Camera: Natus RetCam Envision (130° FOV) · wide-field fundus photograph of an infant · image size 1440x1080 — 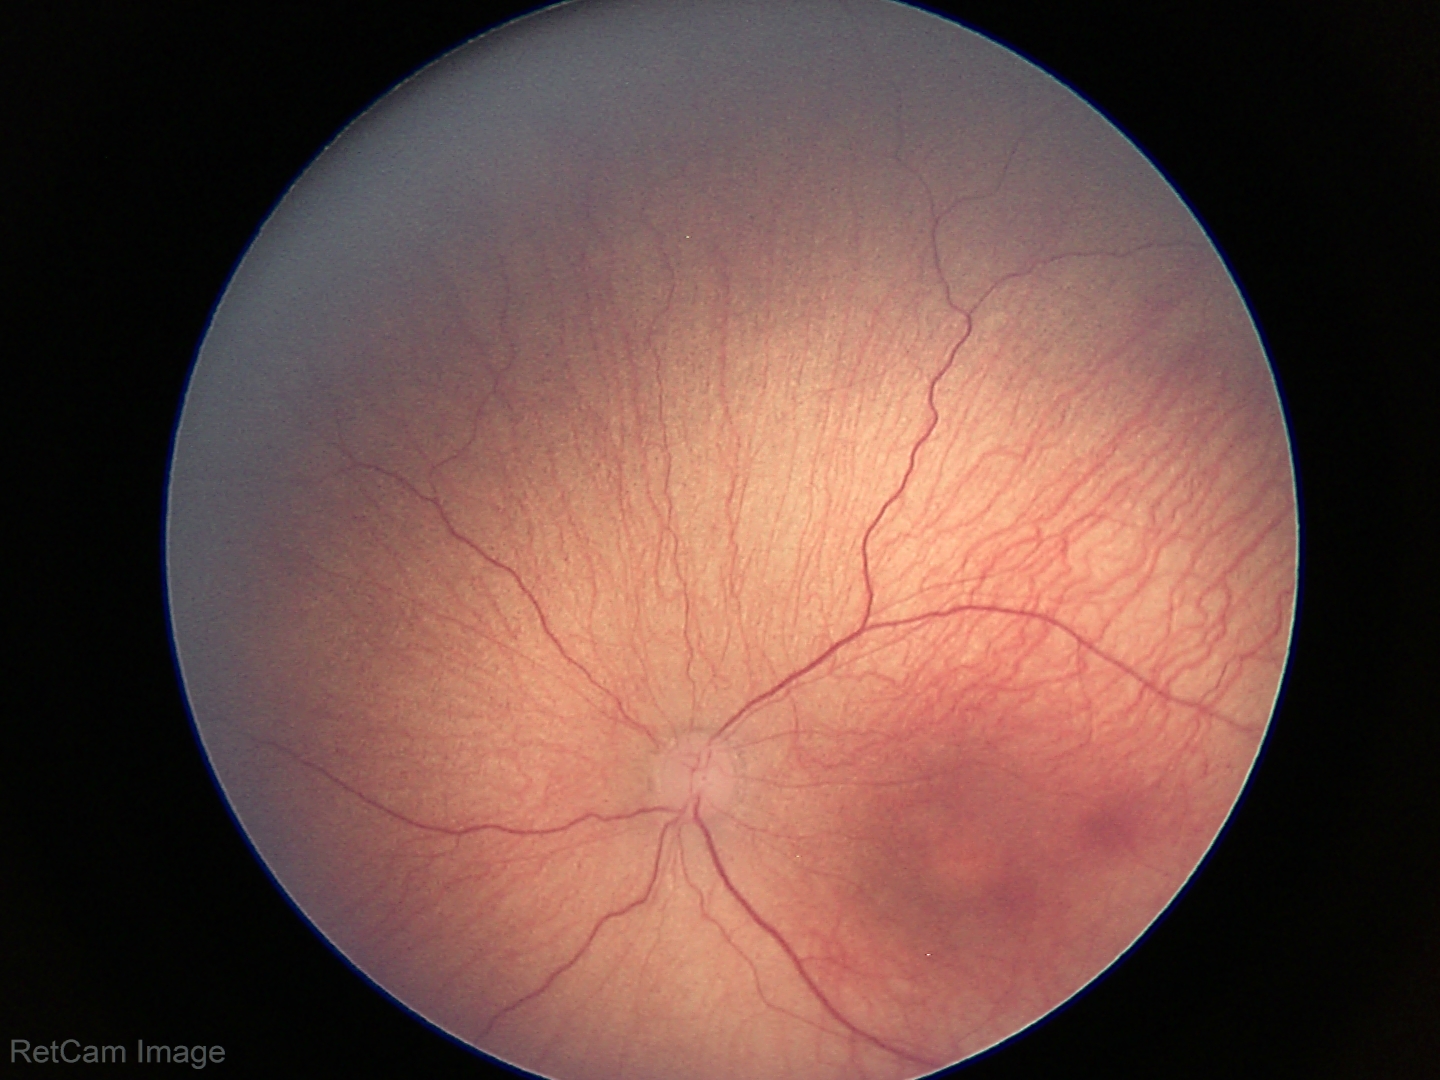

Screening: retinopathy of prematurity (ROP) stage 1 — demarcation line between vascular and avascular retina.